Camera: Phoenix ICON (100° FOV) · wide-field contact fundus photograph of an infant · 1240x1240px.
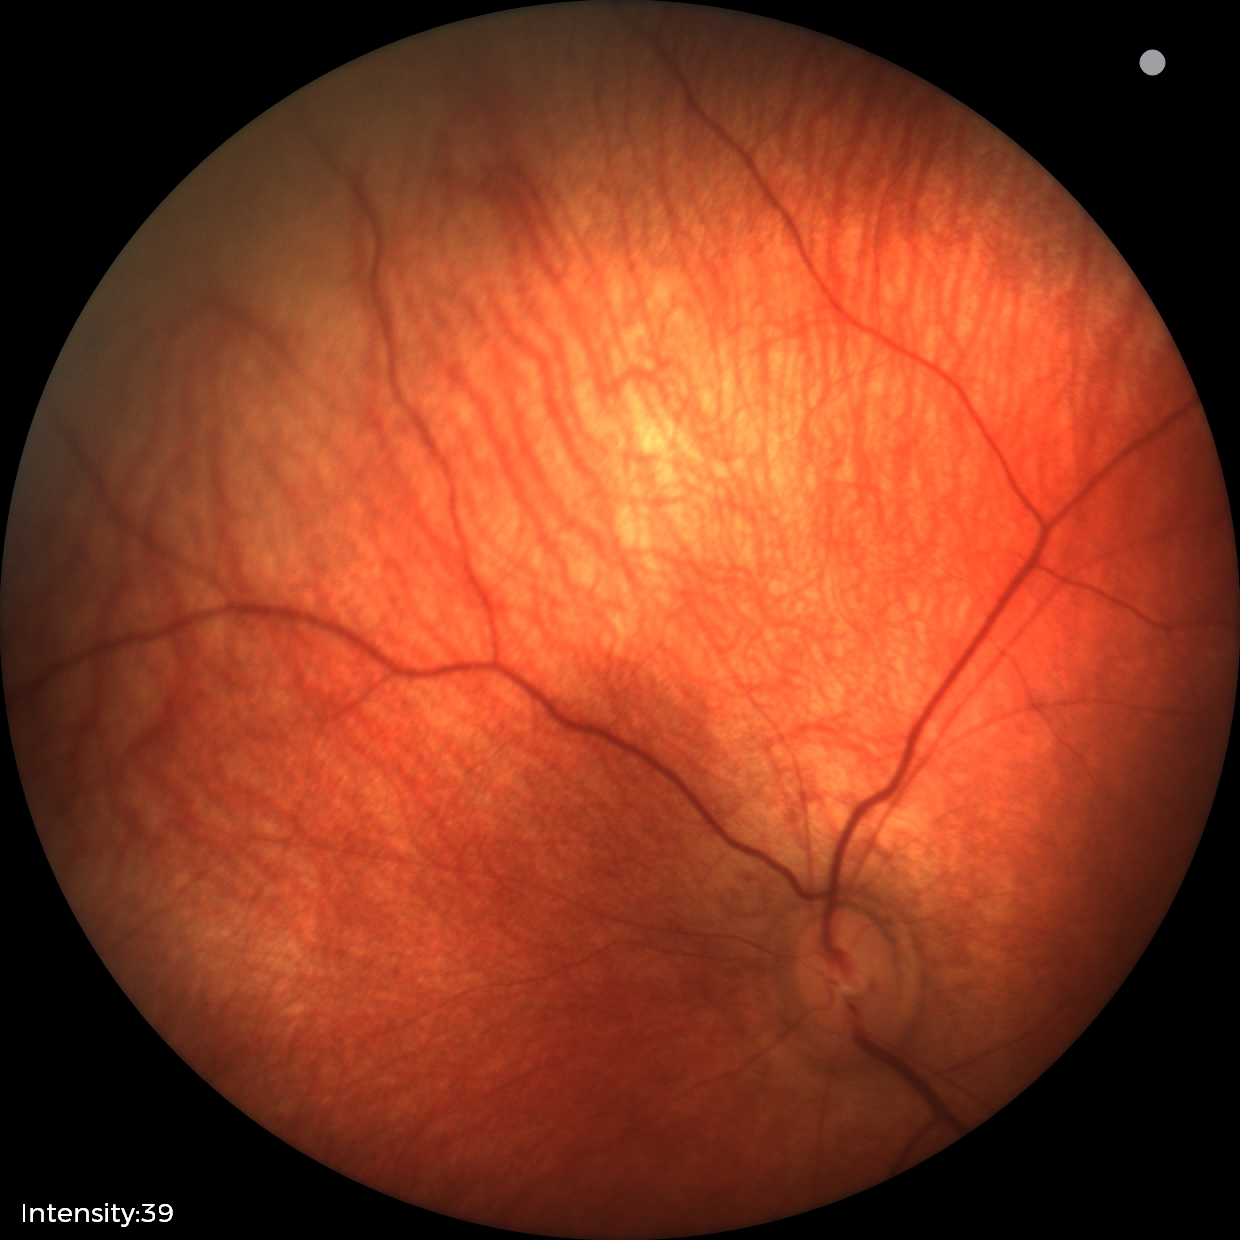

Diagnosis: no abnormalities.